Acquired with a Topcon TRC-50DX. Pupil-dilated. 50° field of view
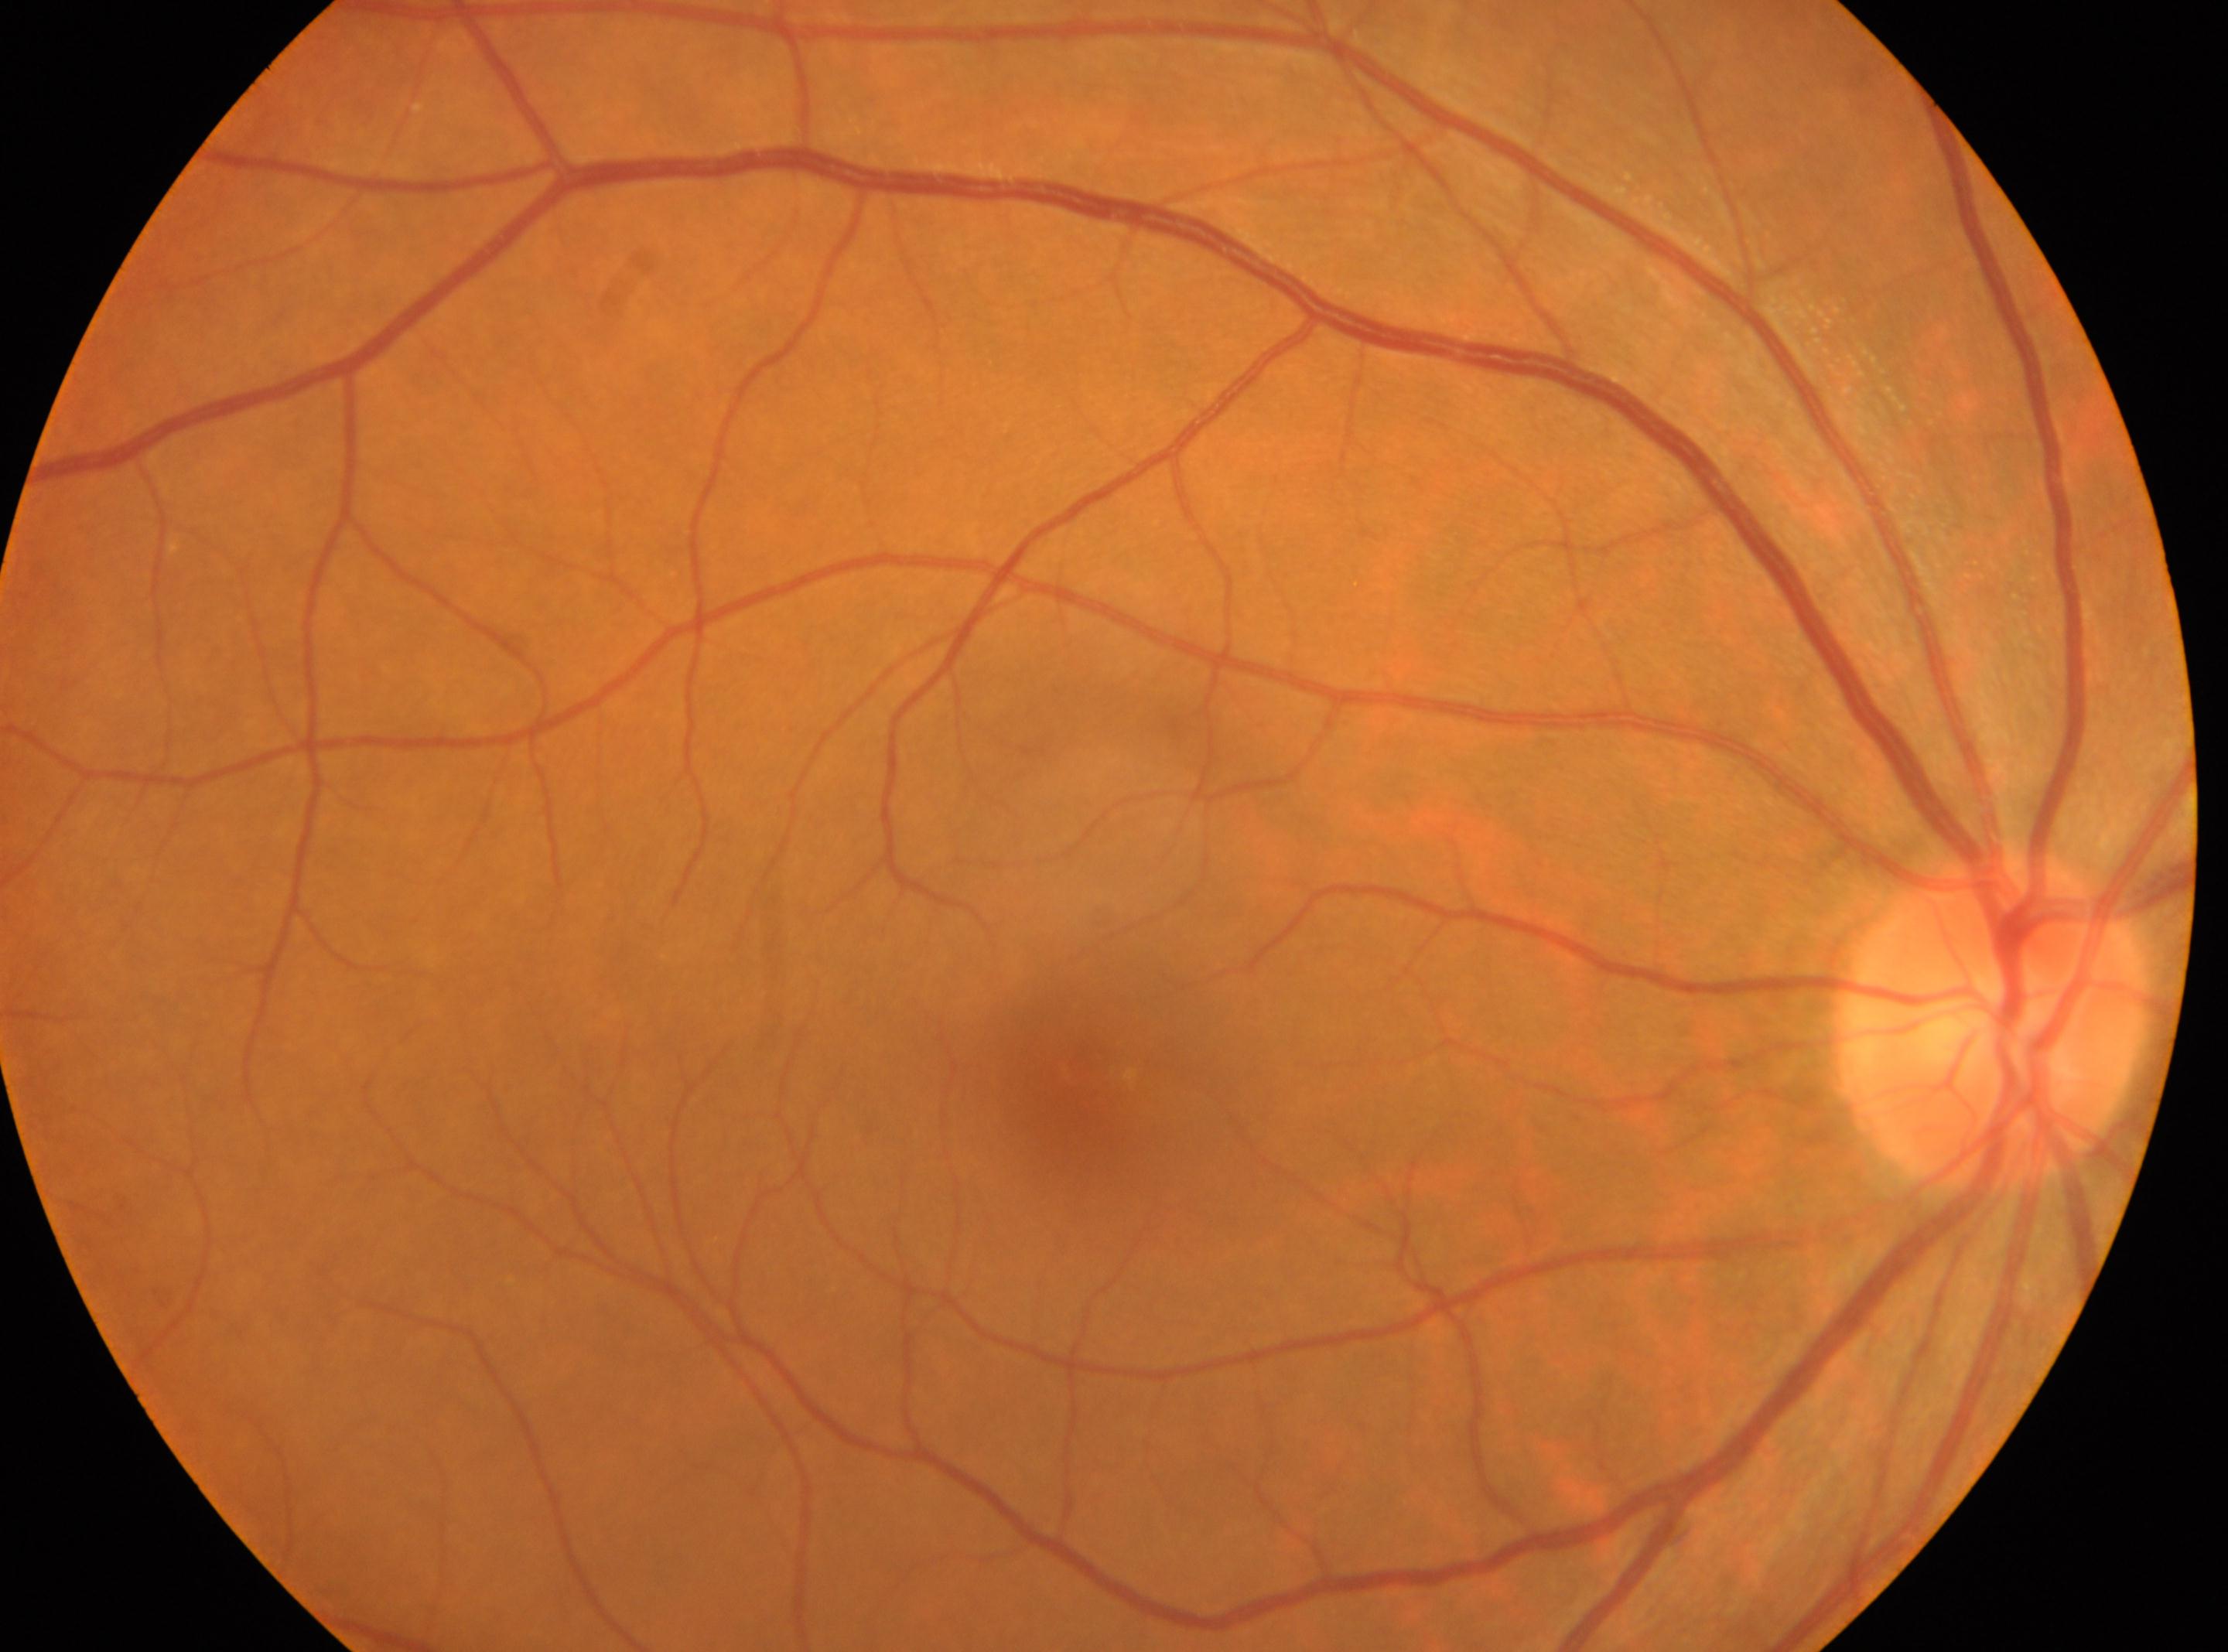

Imaged eye: the right eye. Optic nerve head: (1990,1017). The fovea is at (1085,1067). Retinopathy is grade 0 (no apparent retinopathy) — no visible signs of diabetic retinopathy.